2352 by 1568 pixels: 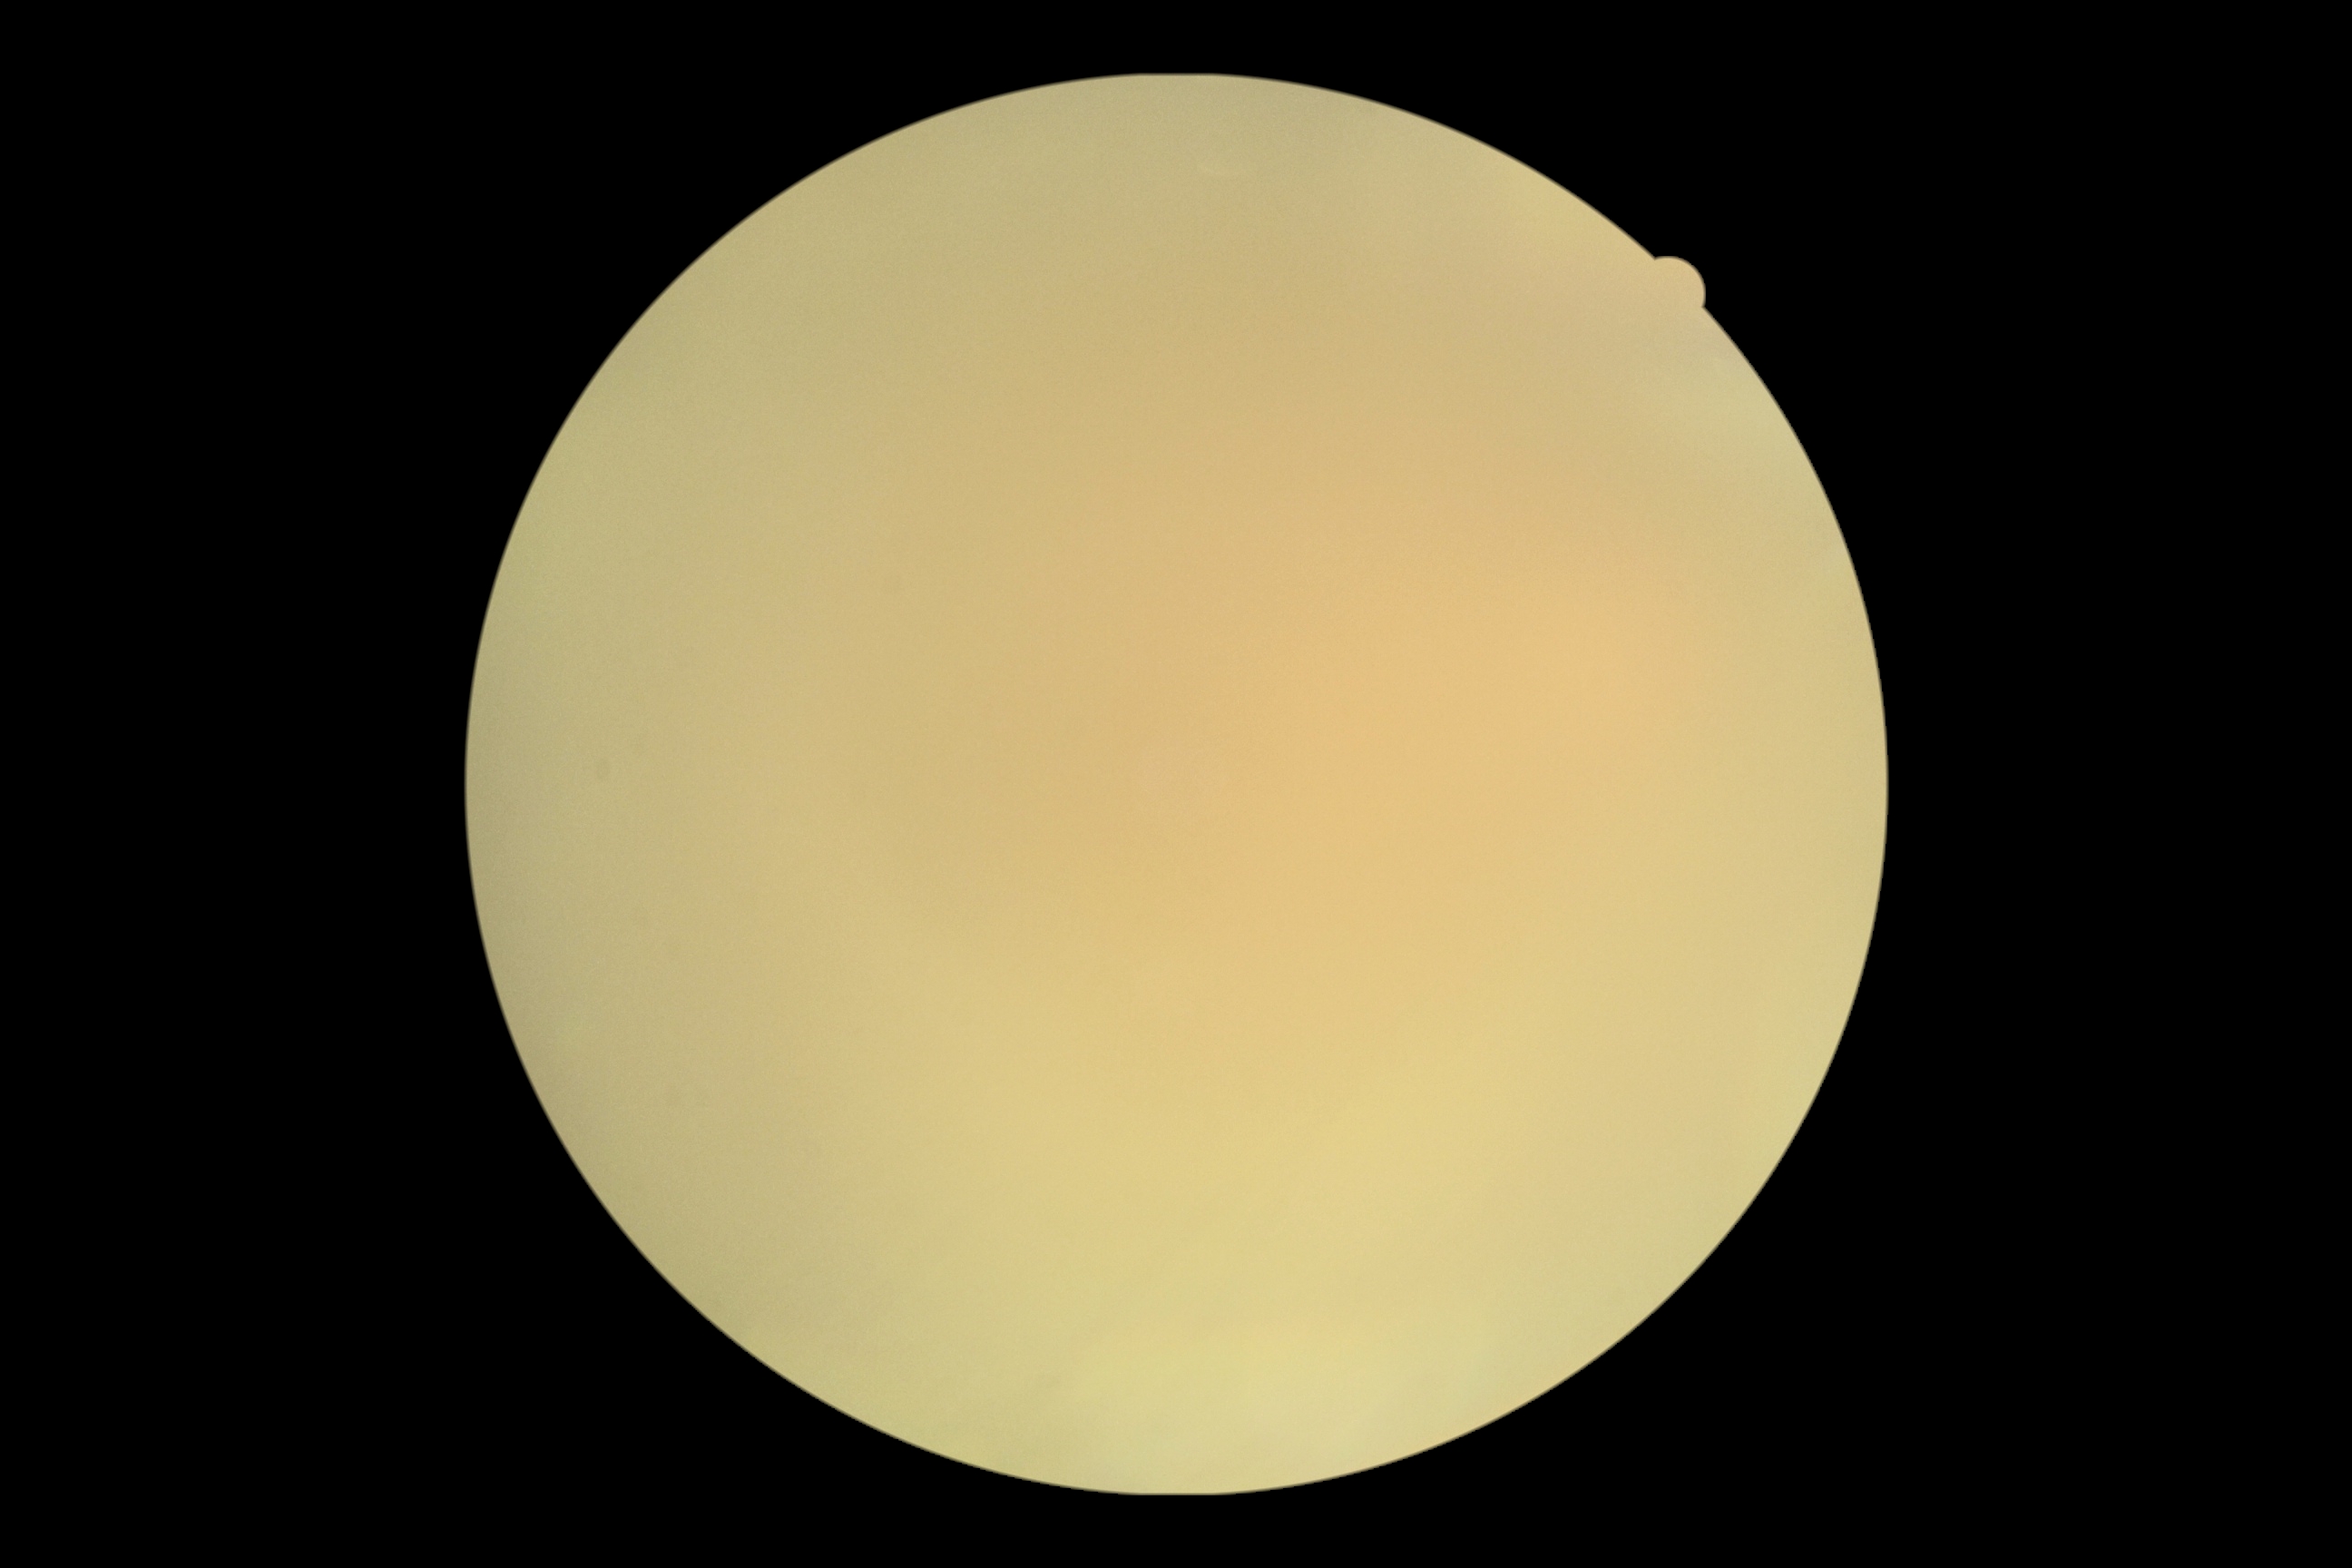

DR stage is ungradable due to poor image quality. Ungradable image — DR severity cannot be determined.